Captured after pupil dilation; 2361x1568; 50° field of view: 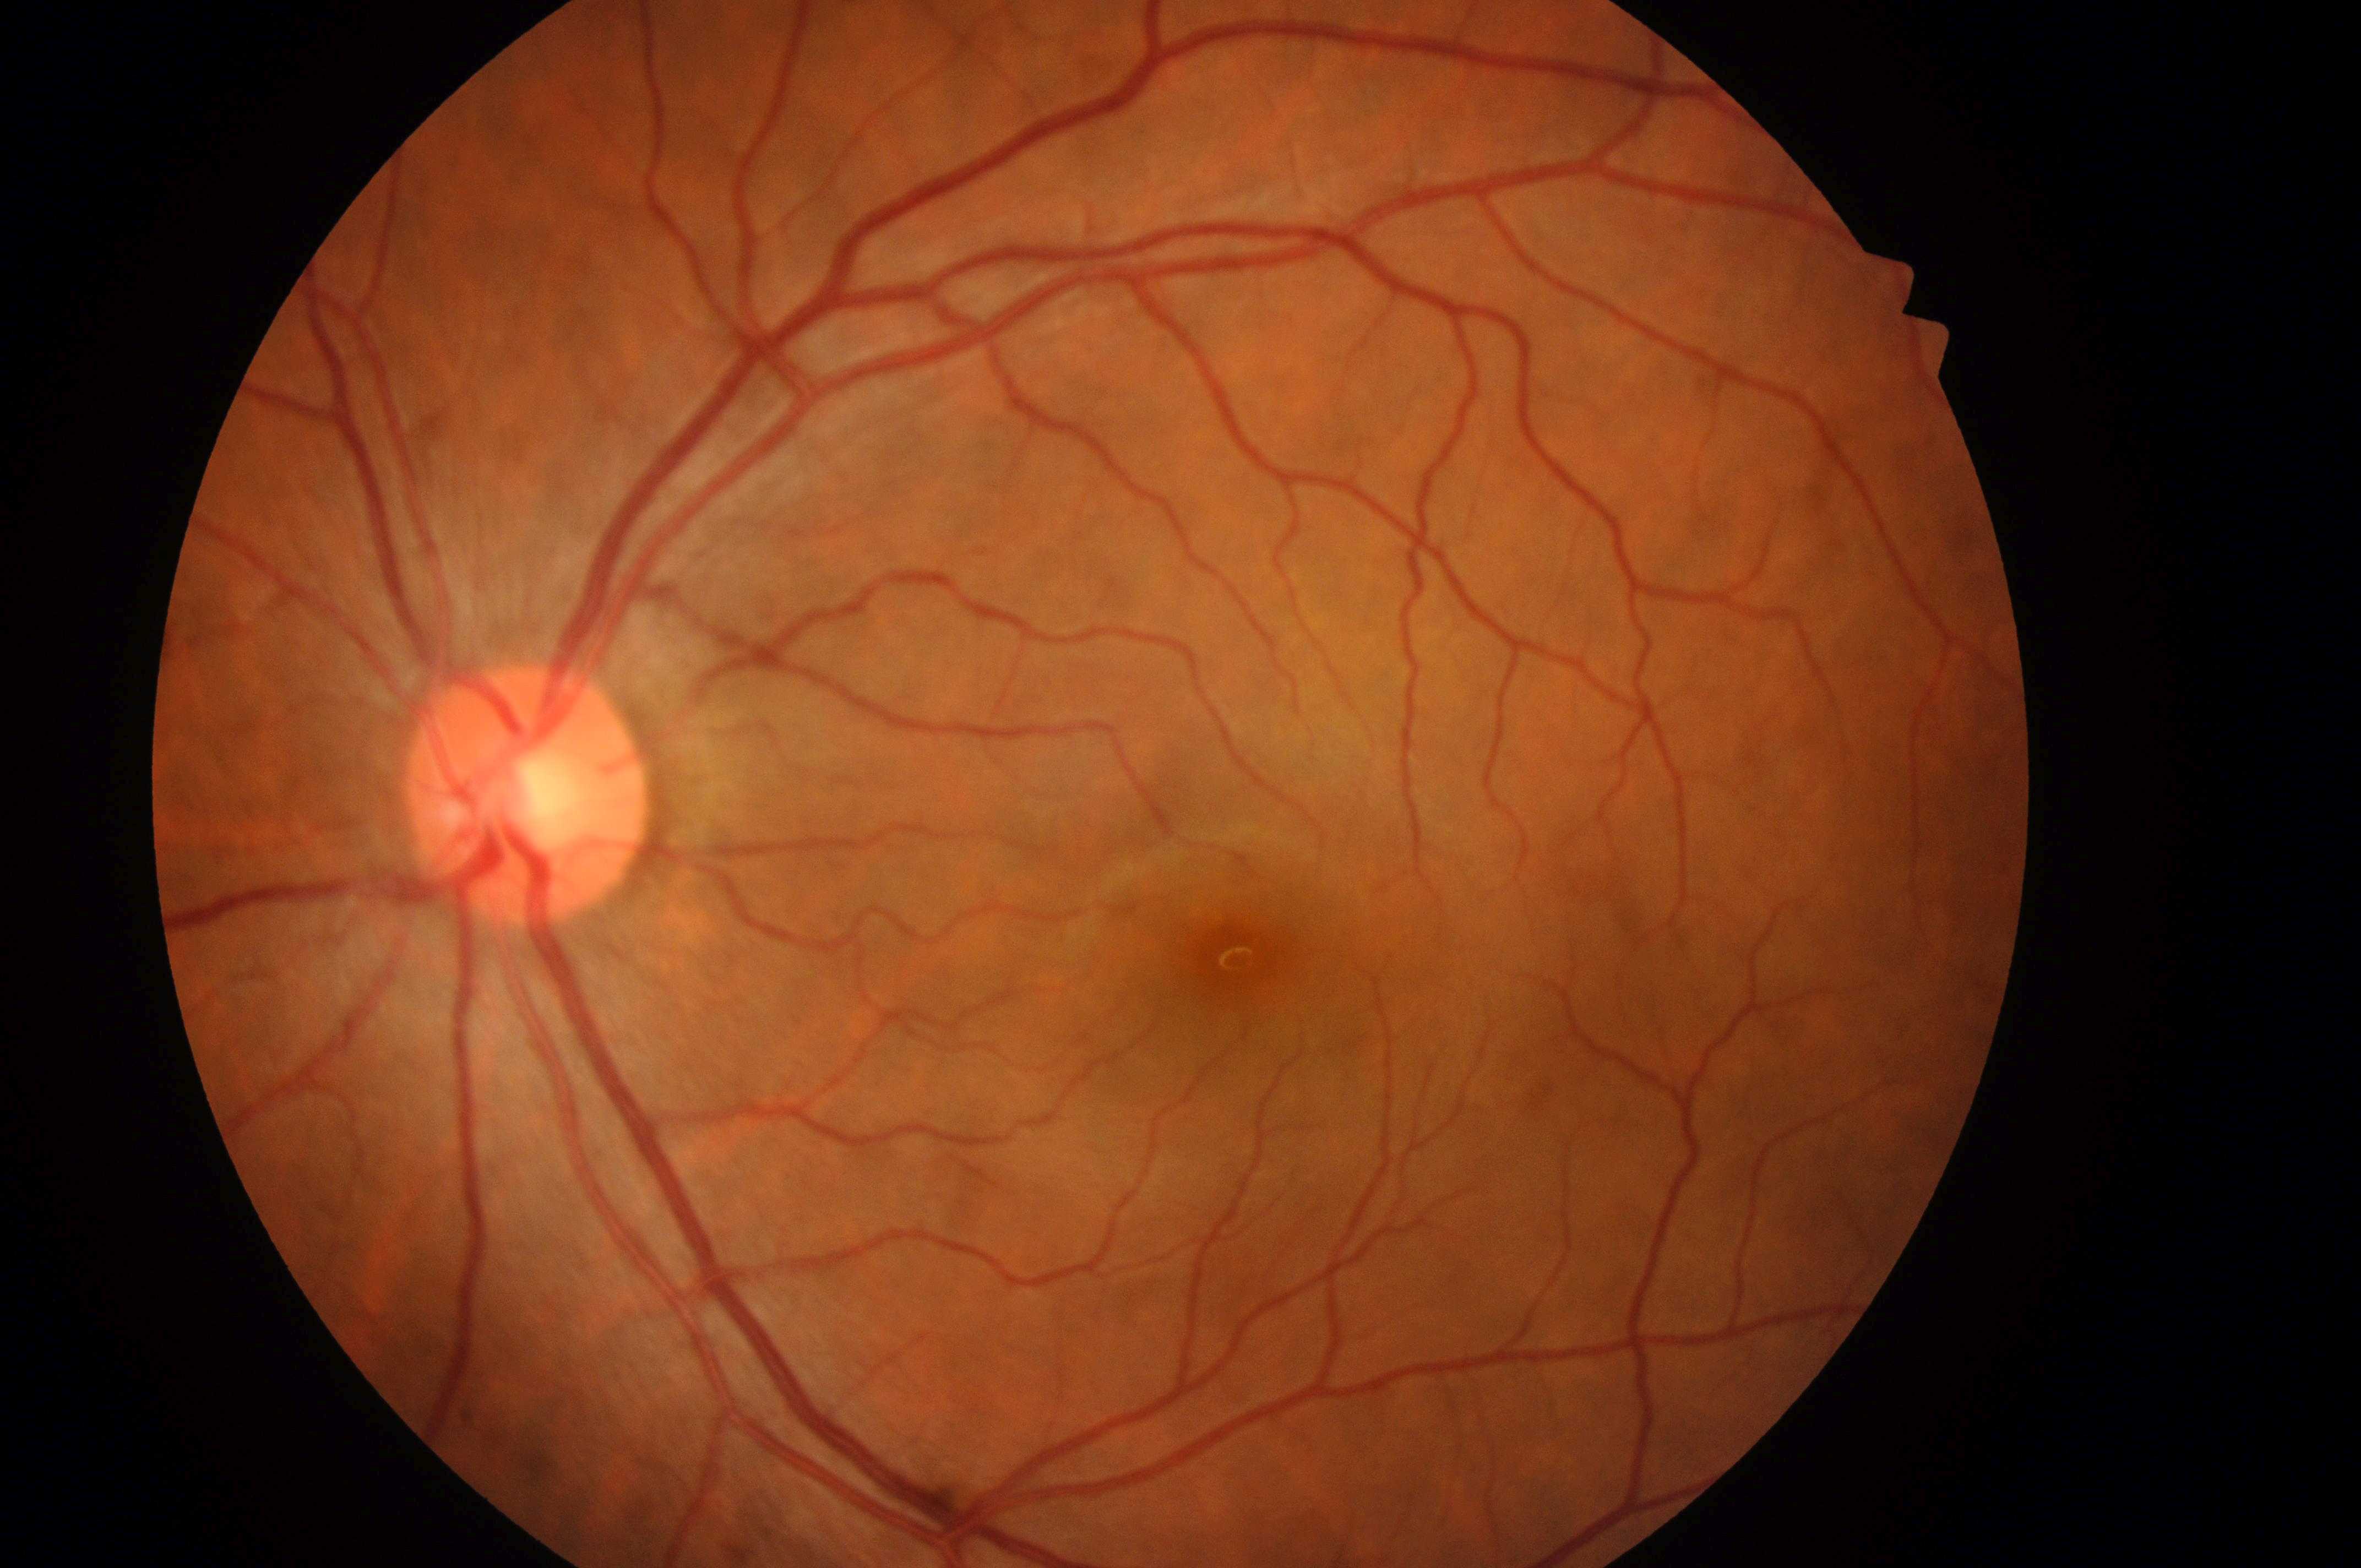

Imaged eye: oculus sinister.
DME grade: no risk (0).
DR grade is 0 (no apparent retinopathy).
Foveal center: x=1238, y=955.
Optic disc center located at x=519, y=806.